Modified Davis grading, nonmydriatic, posterior pole photograph
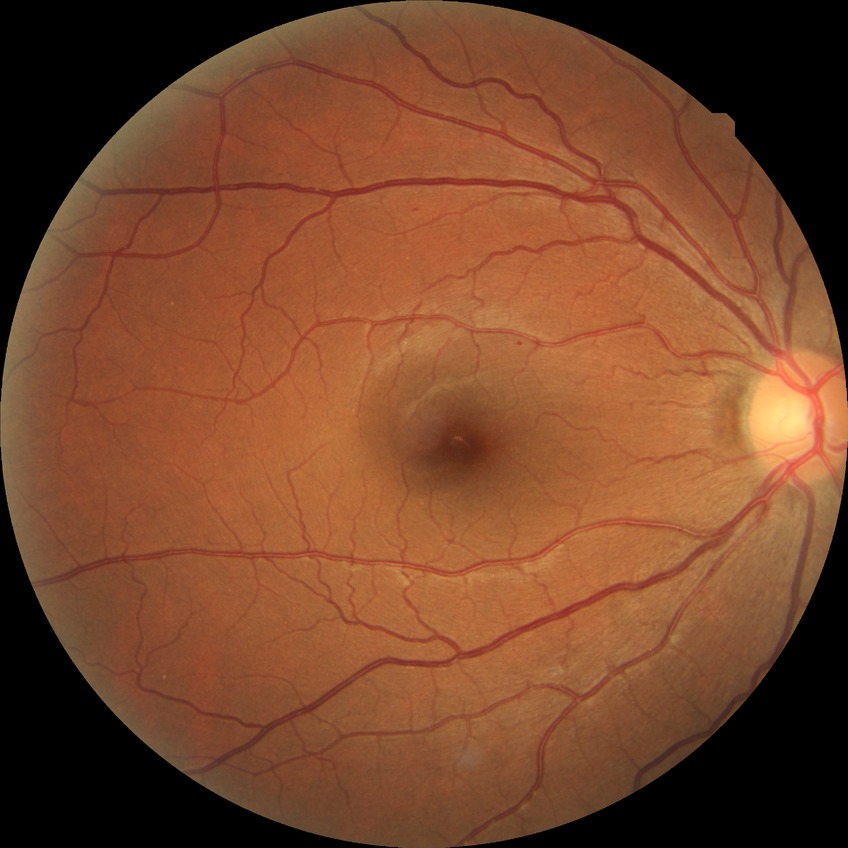 Assessment:
- diabetic retinopathy stage — simple diabetic retinopathy